2212 by 1659 pixels:
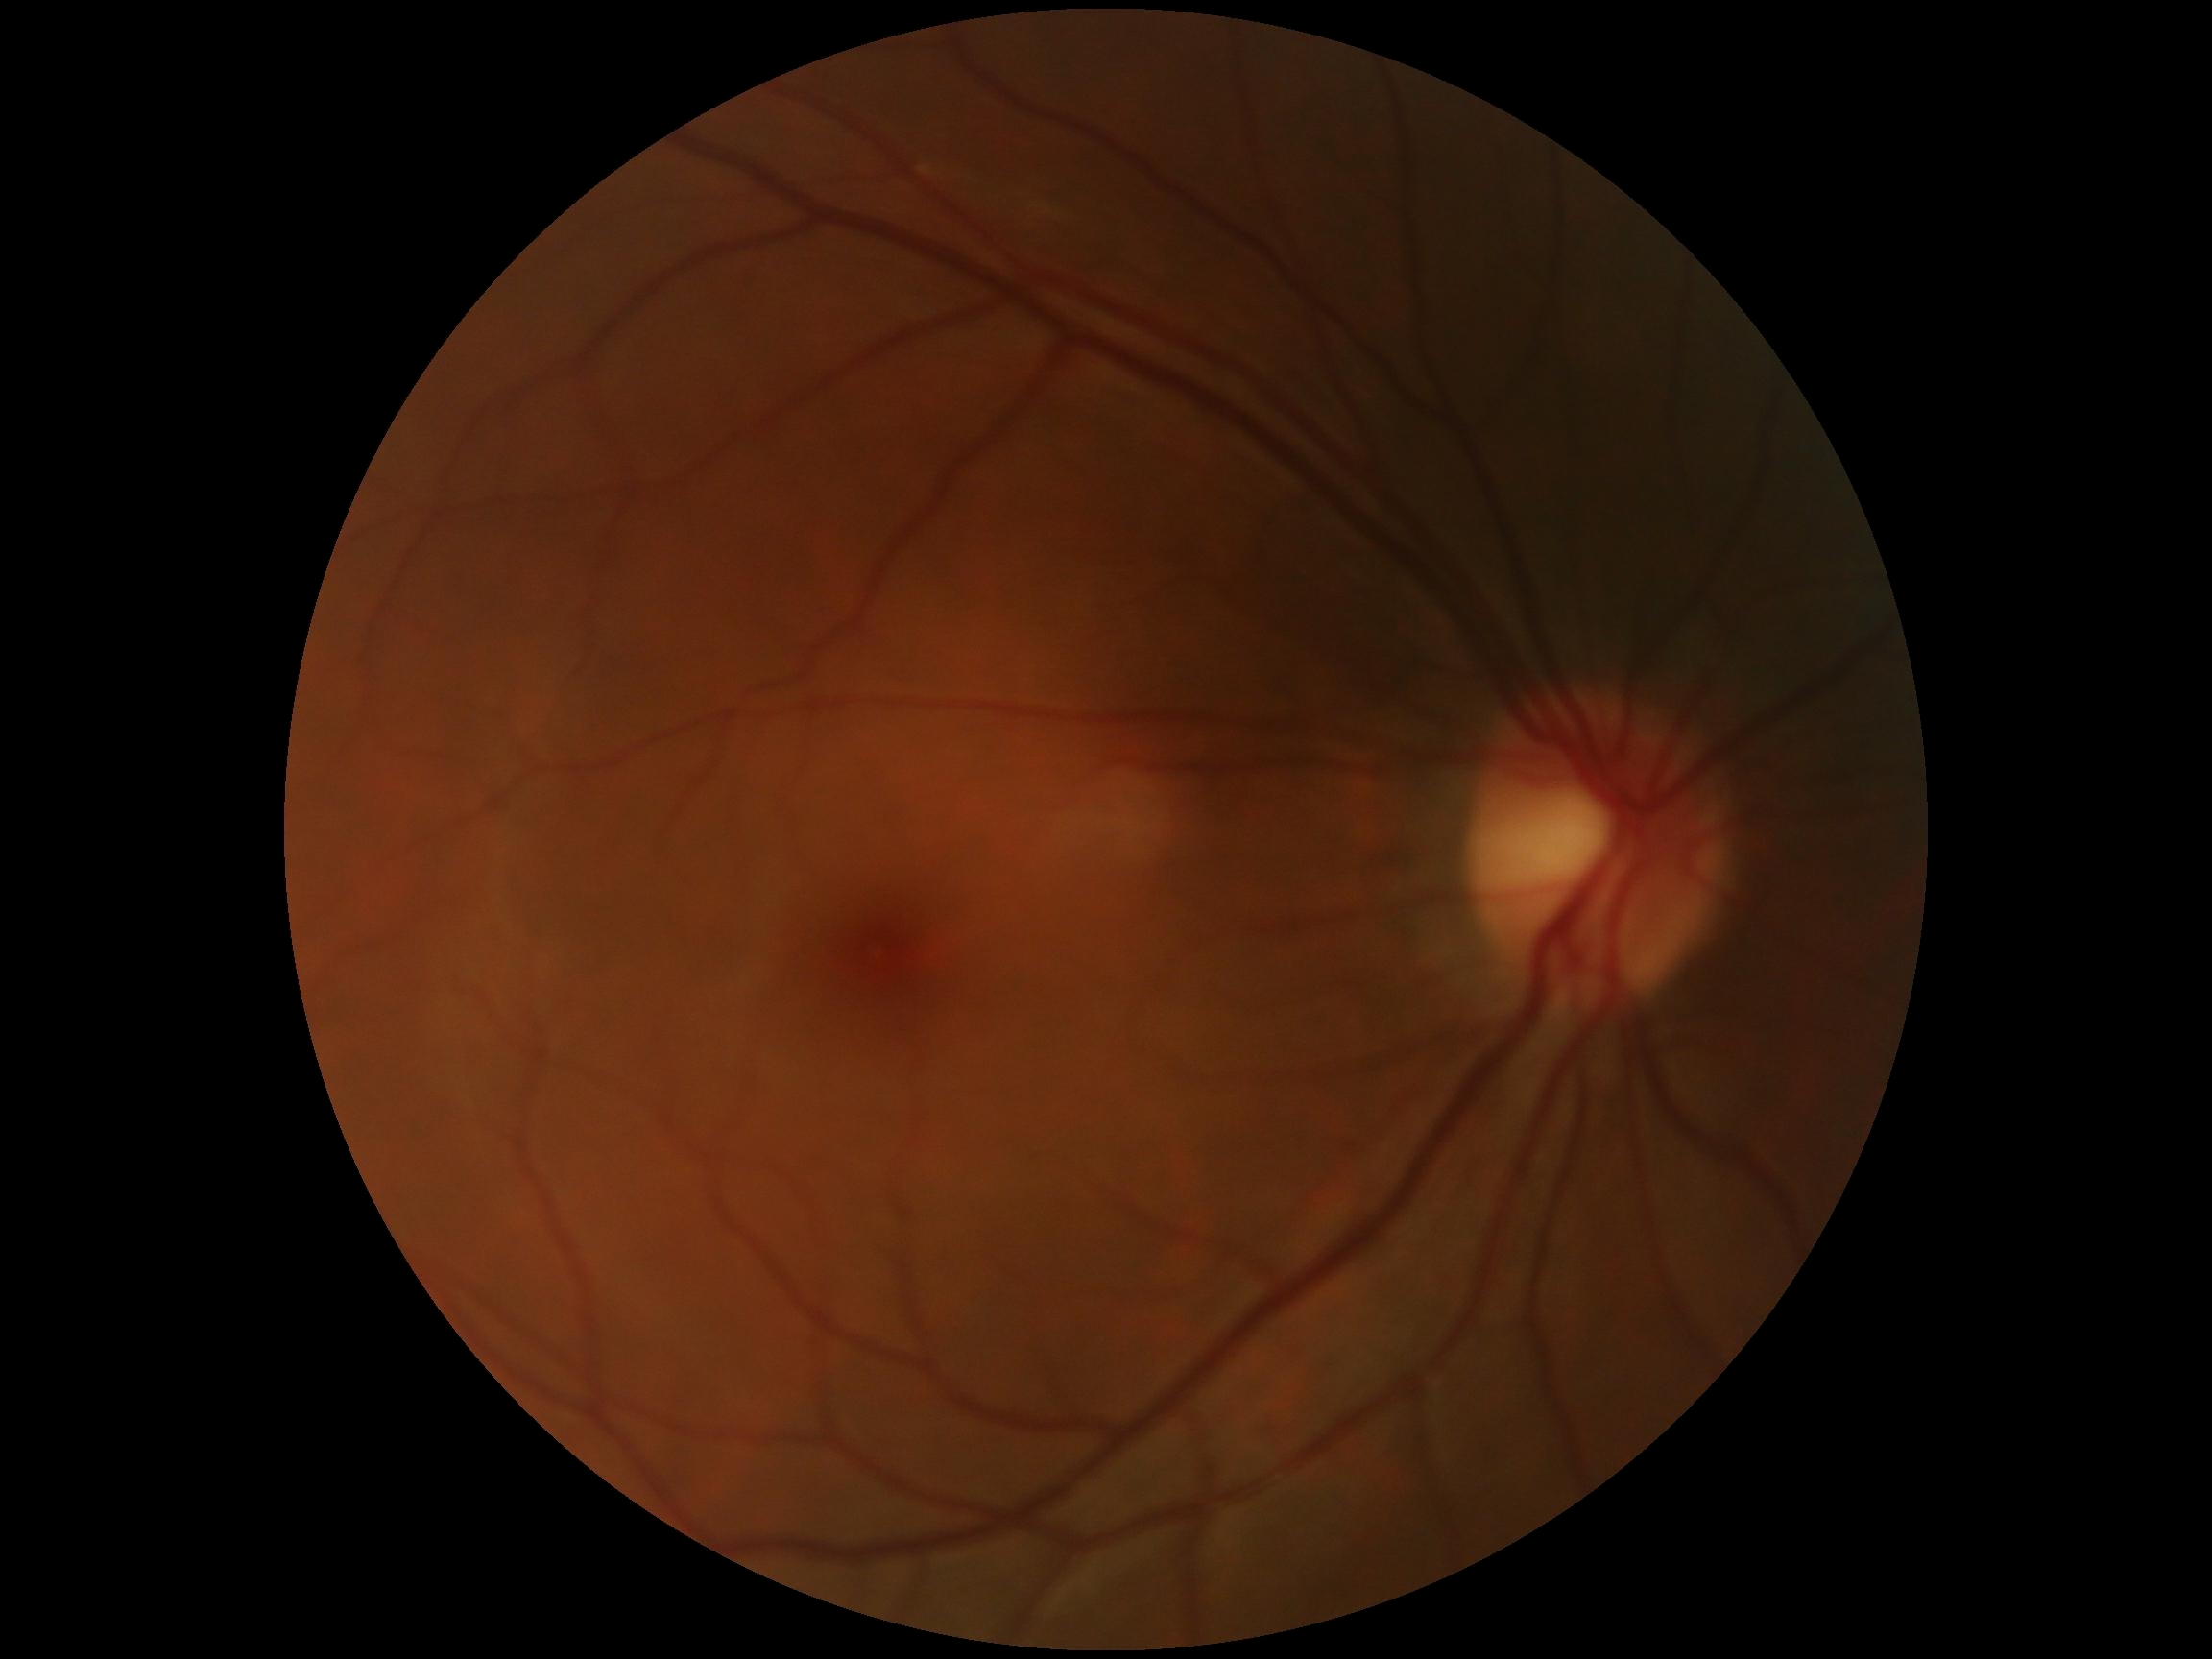 Diabetic retinopathy (DR) is no apparent diabetic retinopathy (grade 0).